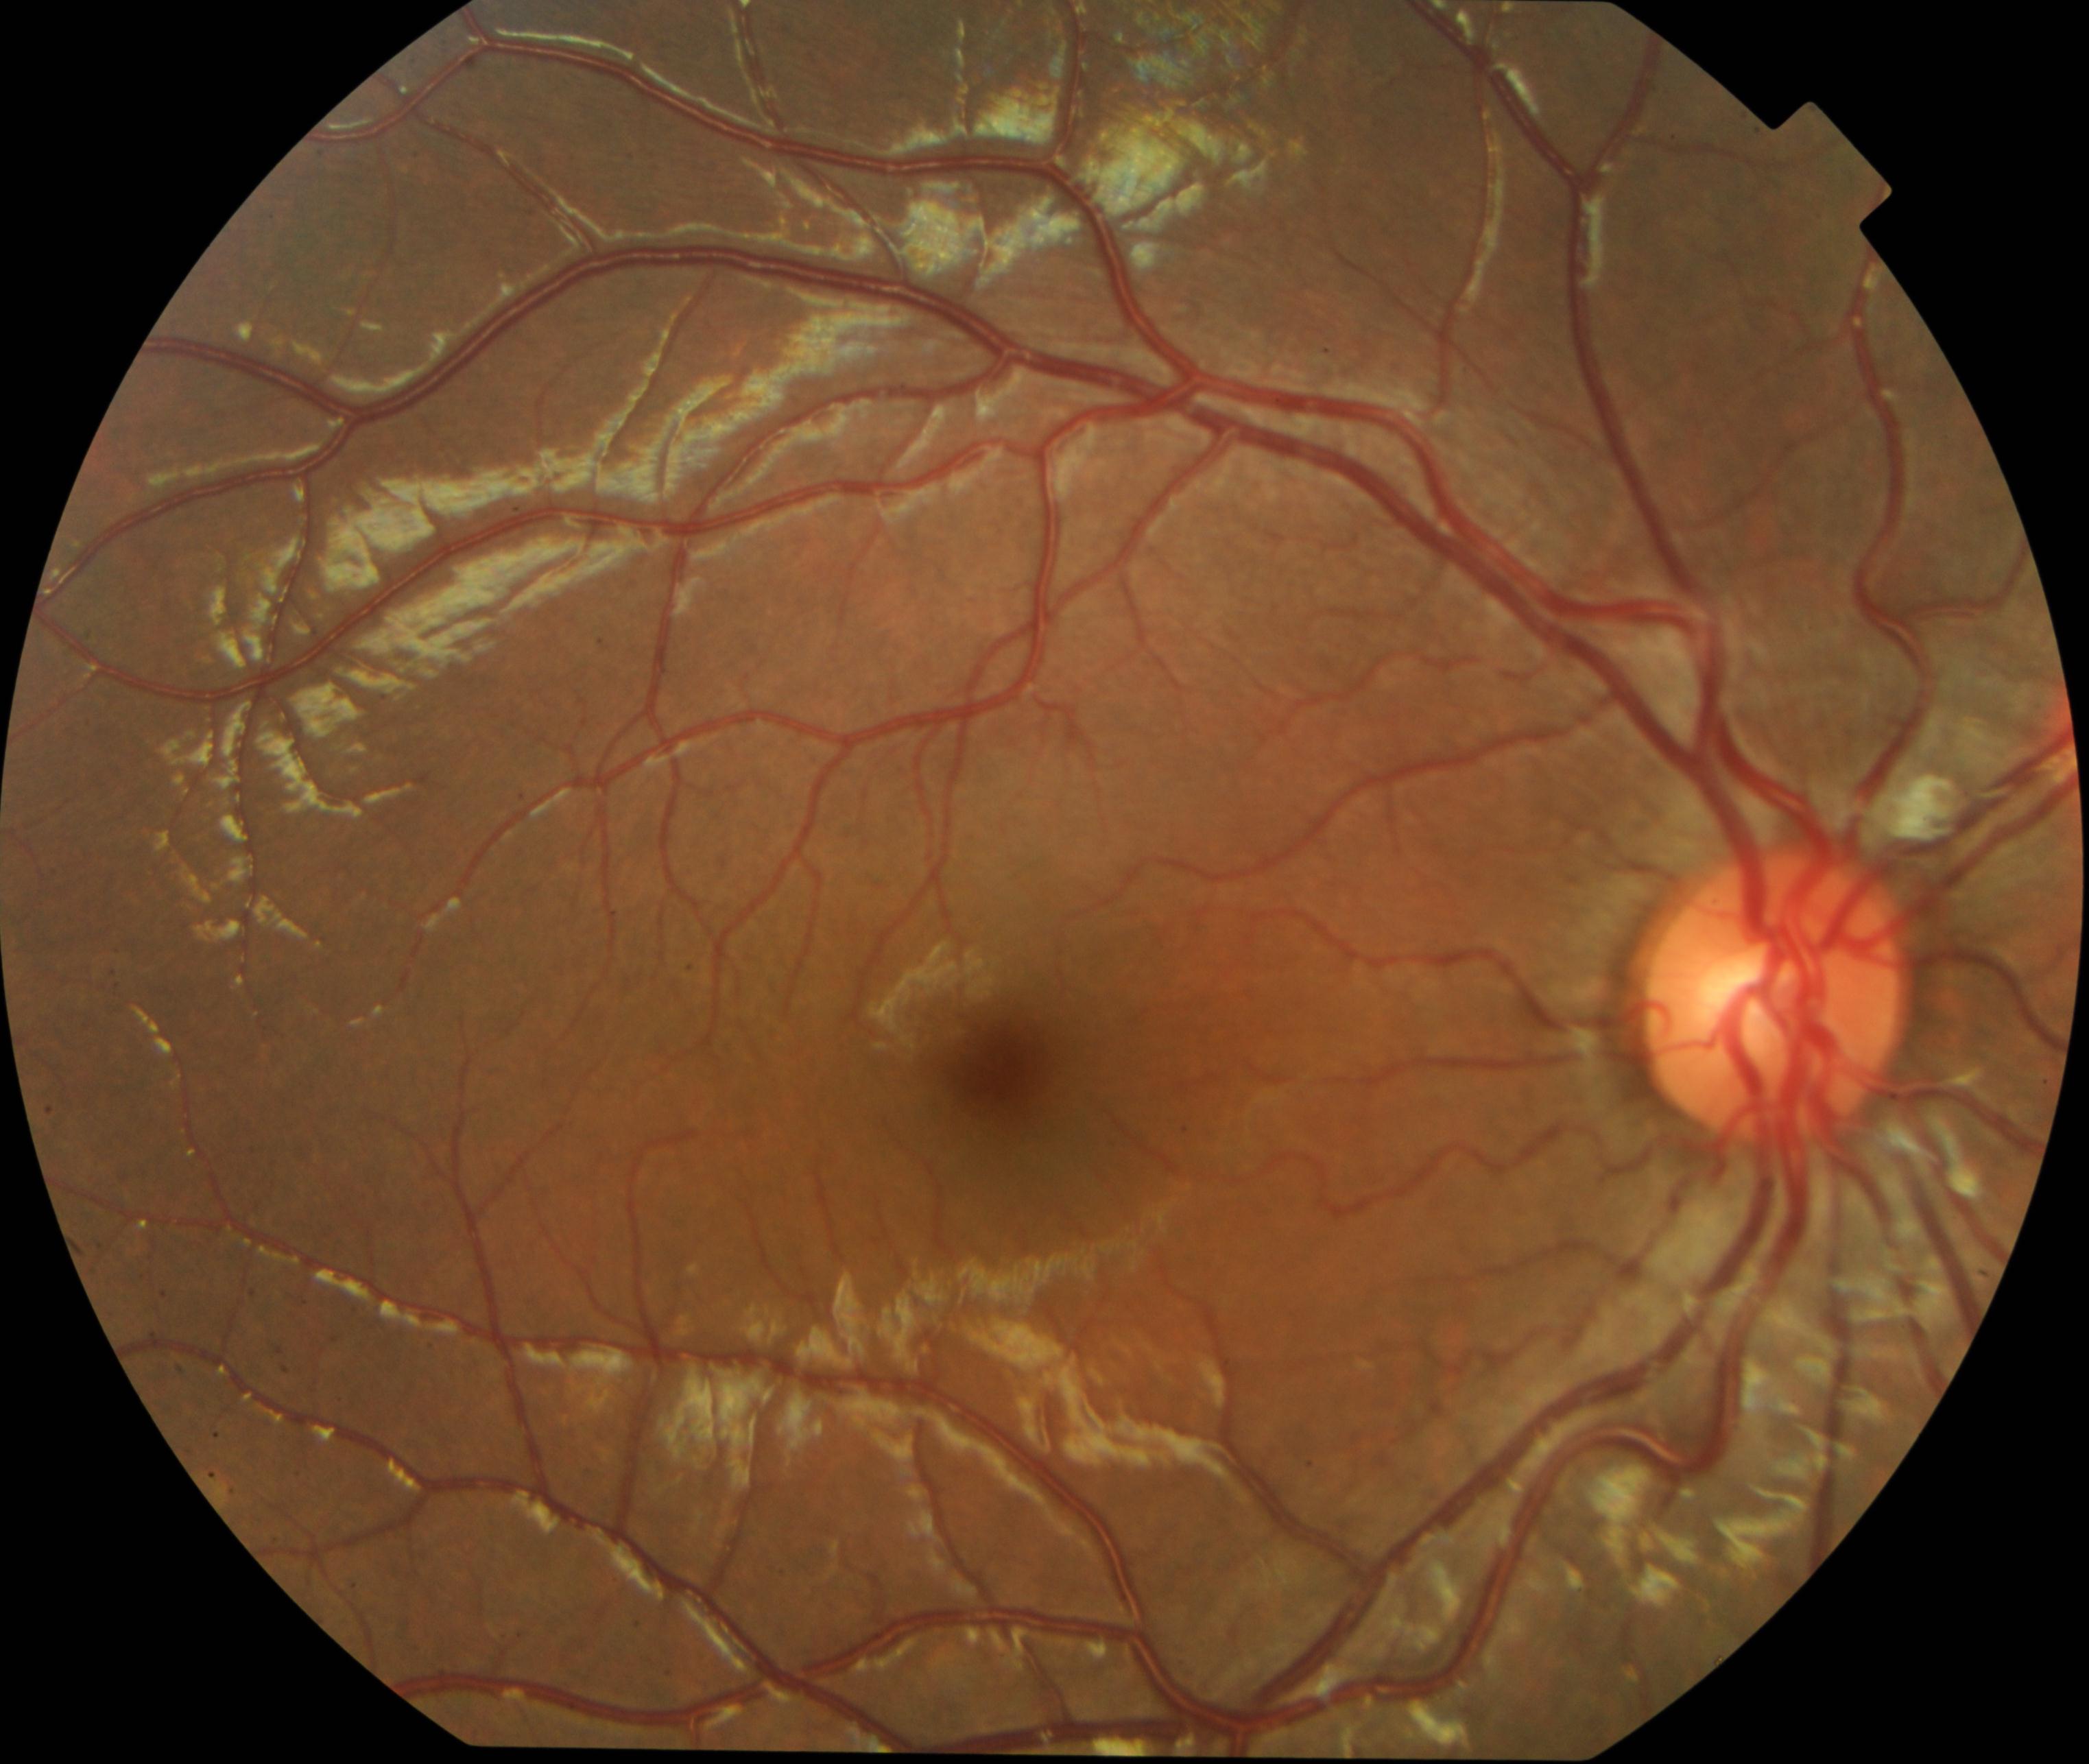 Classification: vessel tortuosity.